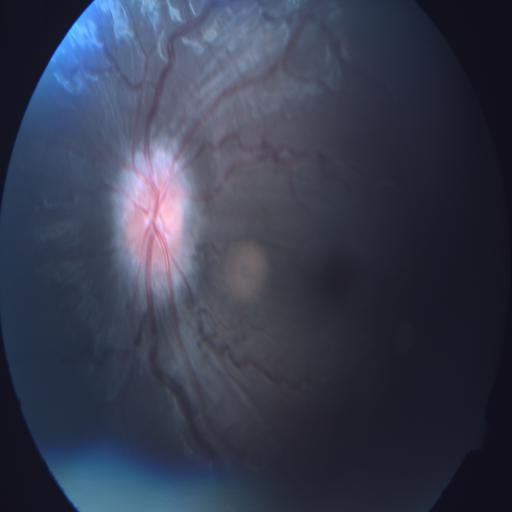

Showing optic disc edema.